Fundus photo.
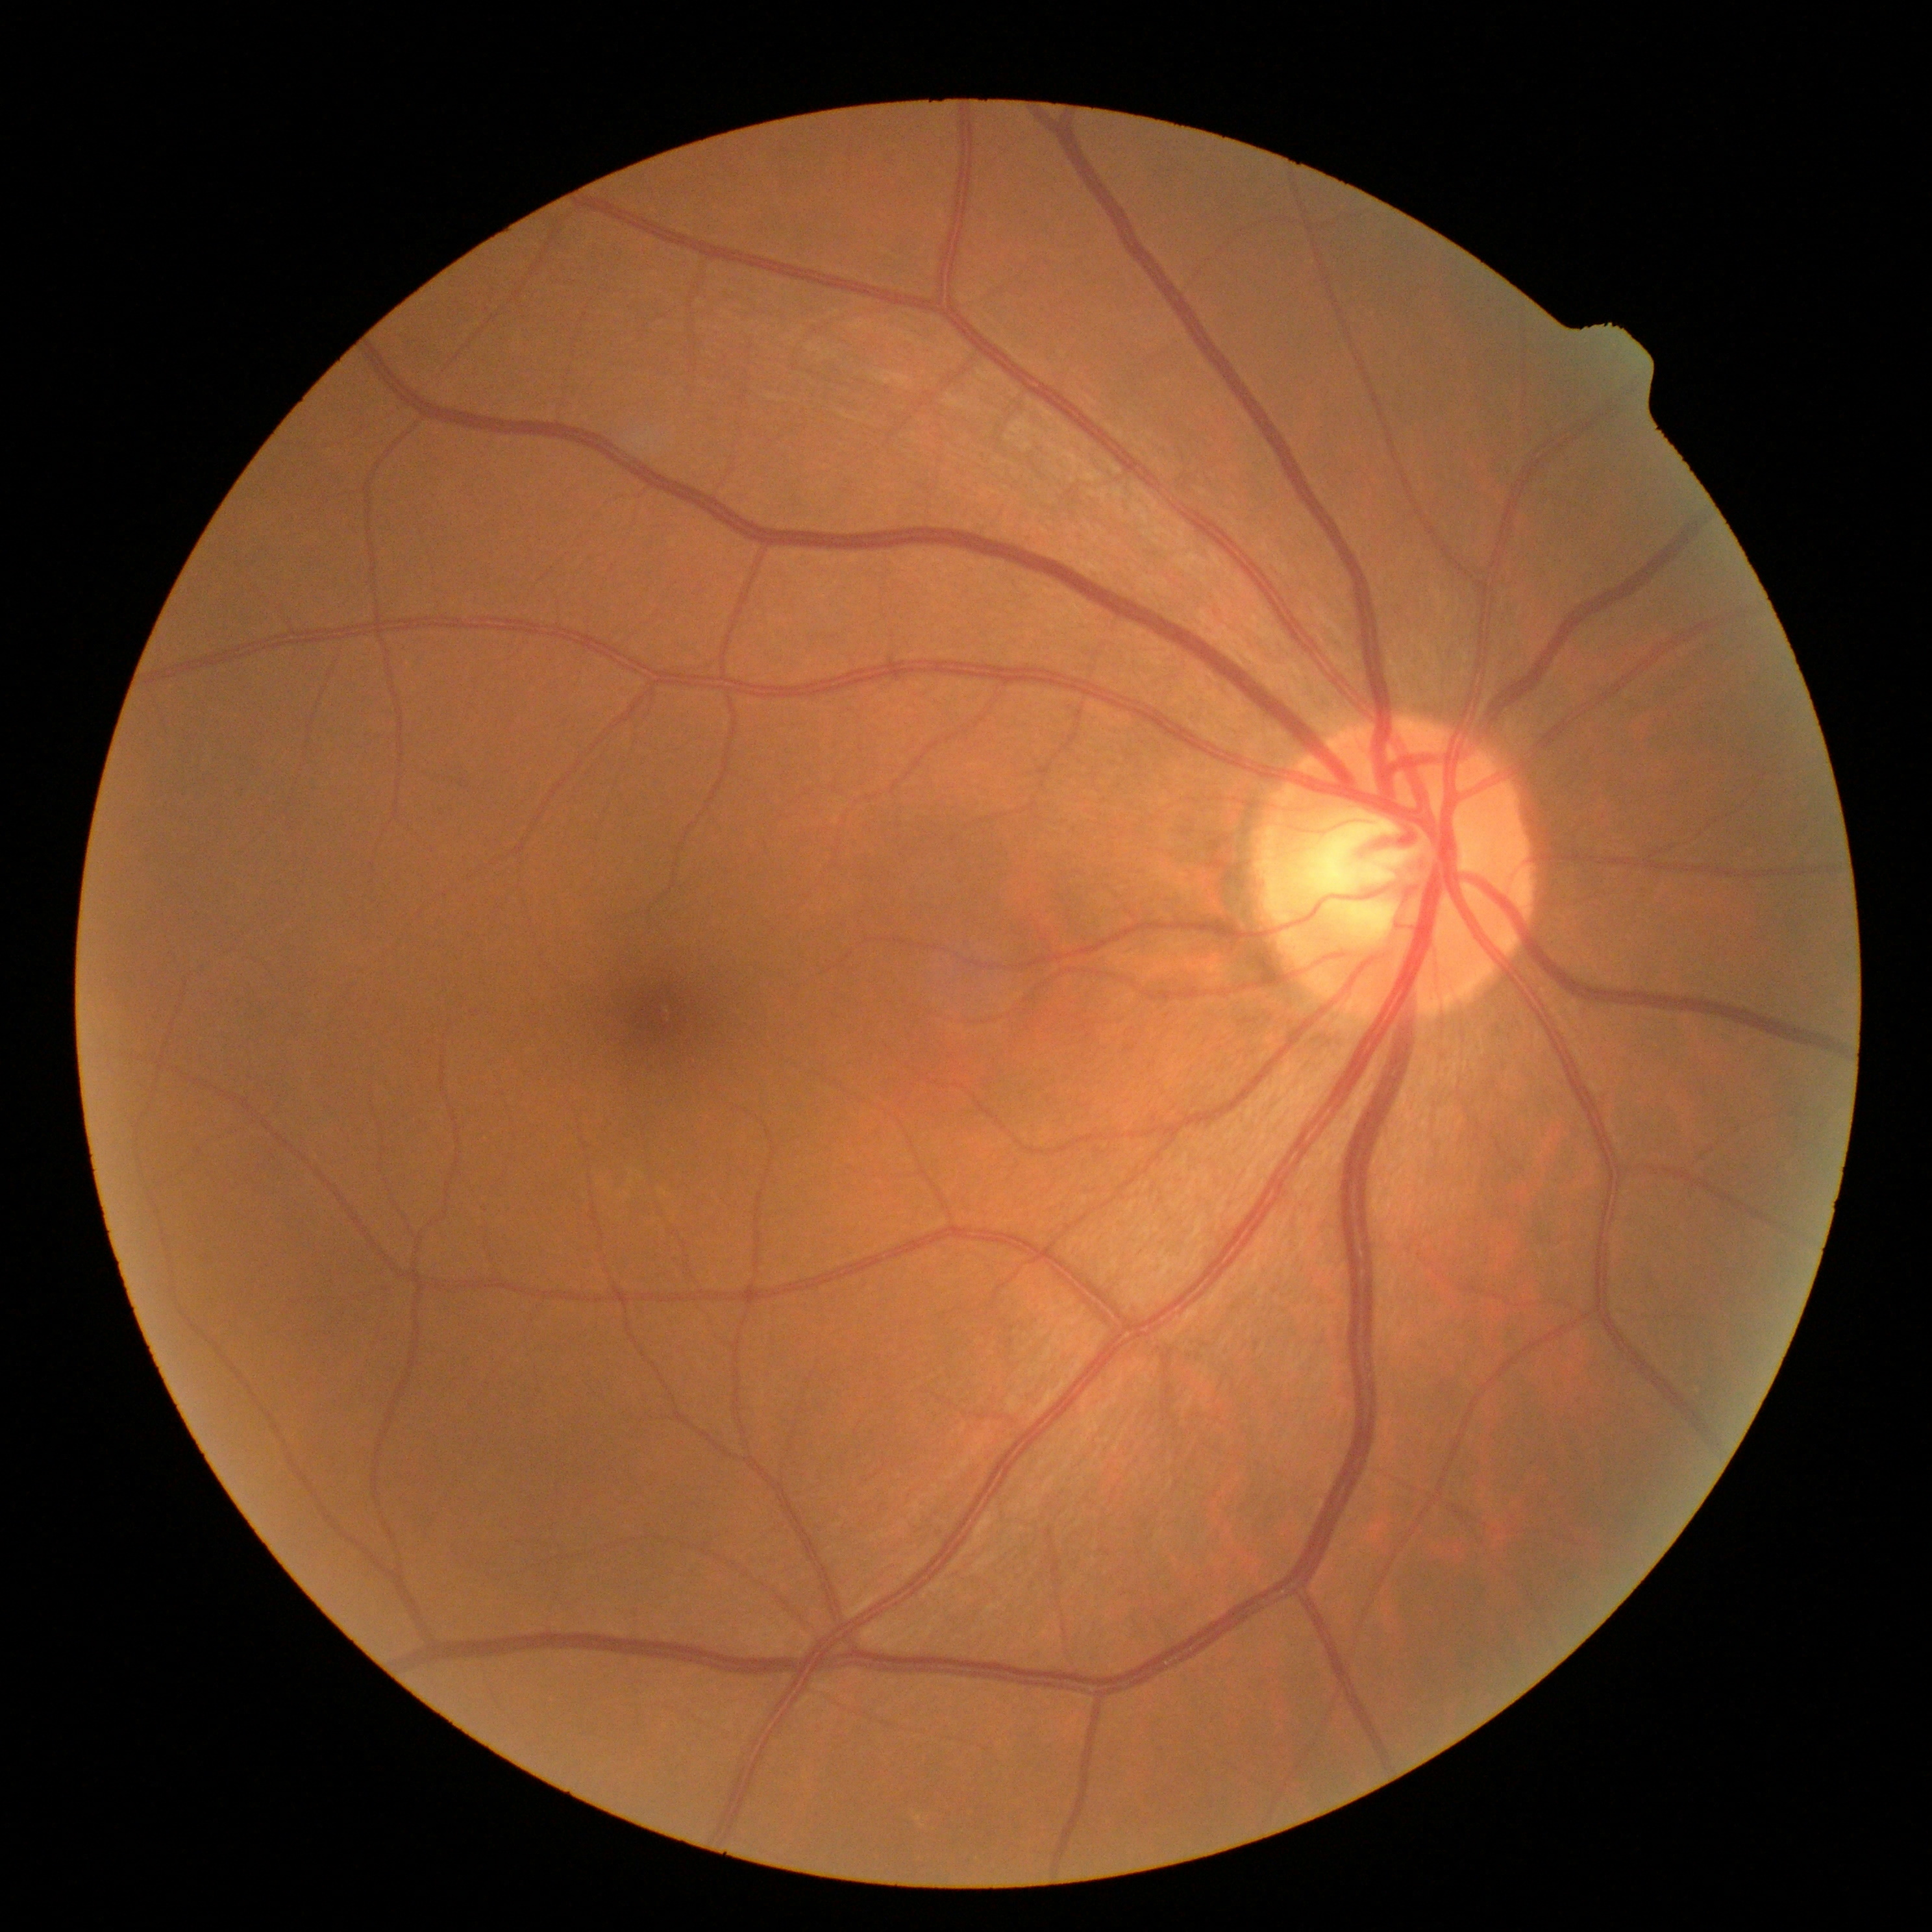

DR is grade 0 (no apparent retinopathy).